Posterior pole color fundus photograph: 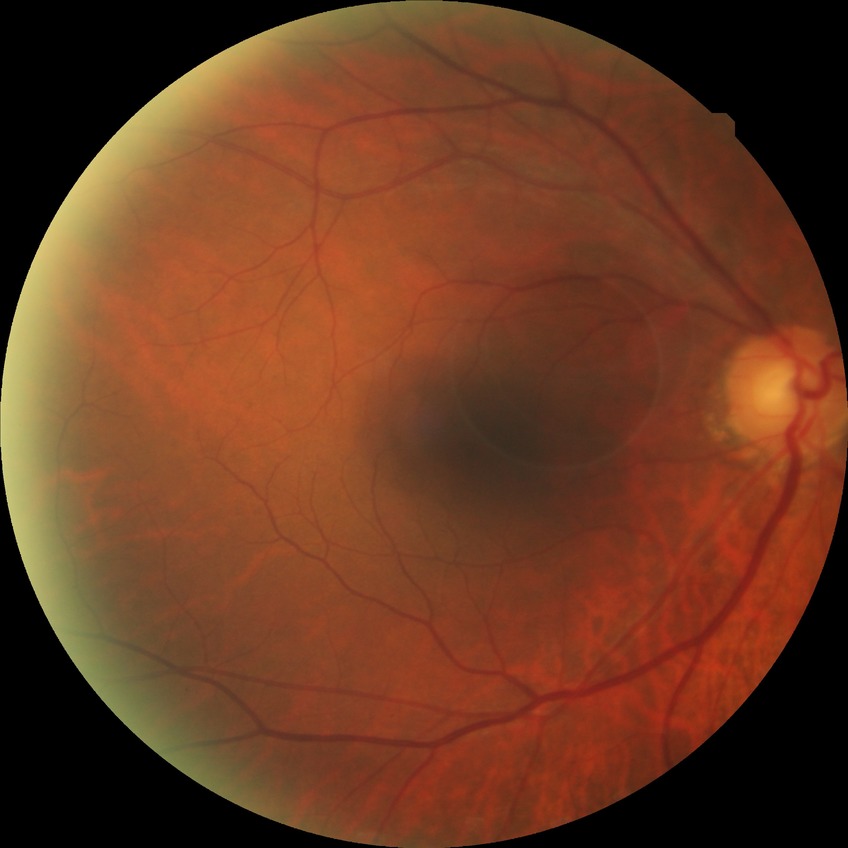
Findings:
* modified Davis grading: no diabetic retinopathy